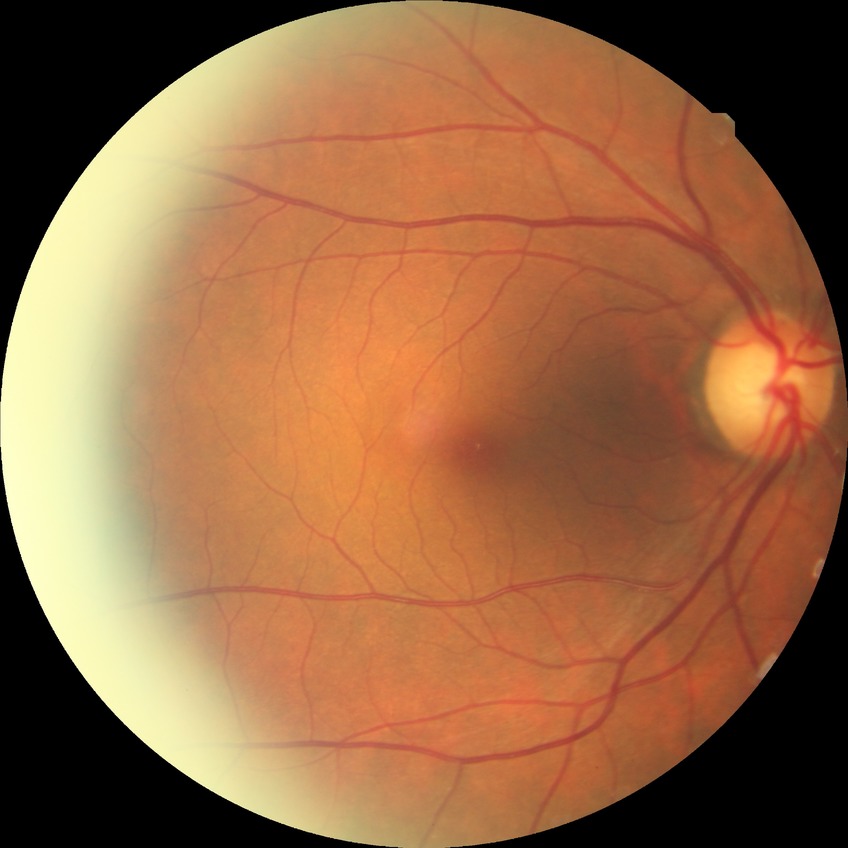

diabetic retinopathy (DR) = NDR (no diabetic retinopathy)